Ultra-widefield fundus photograph.
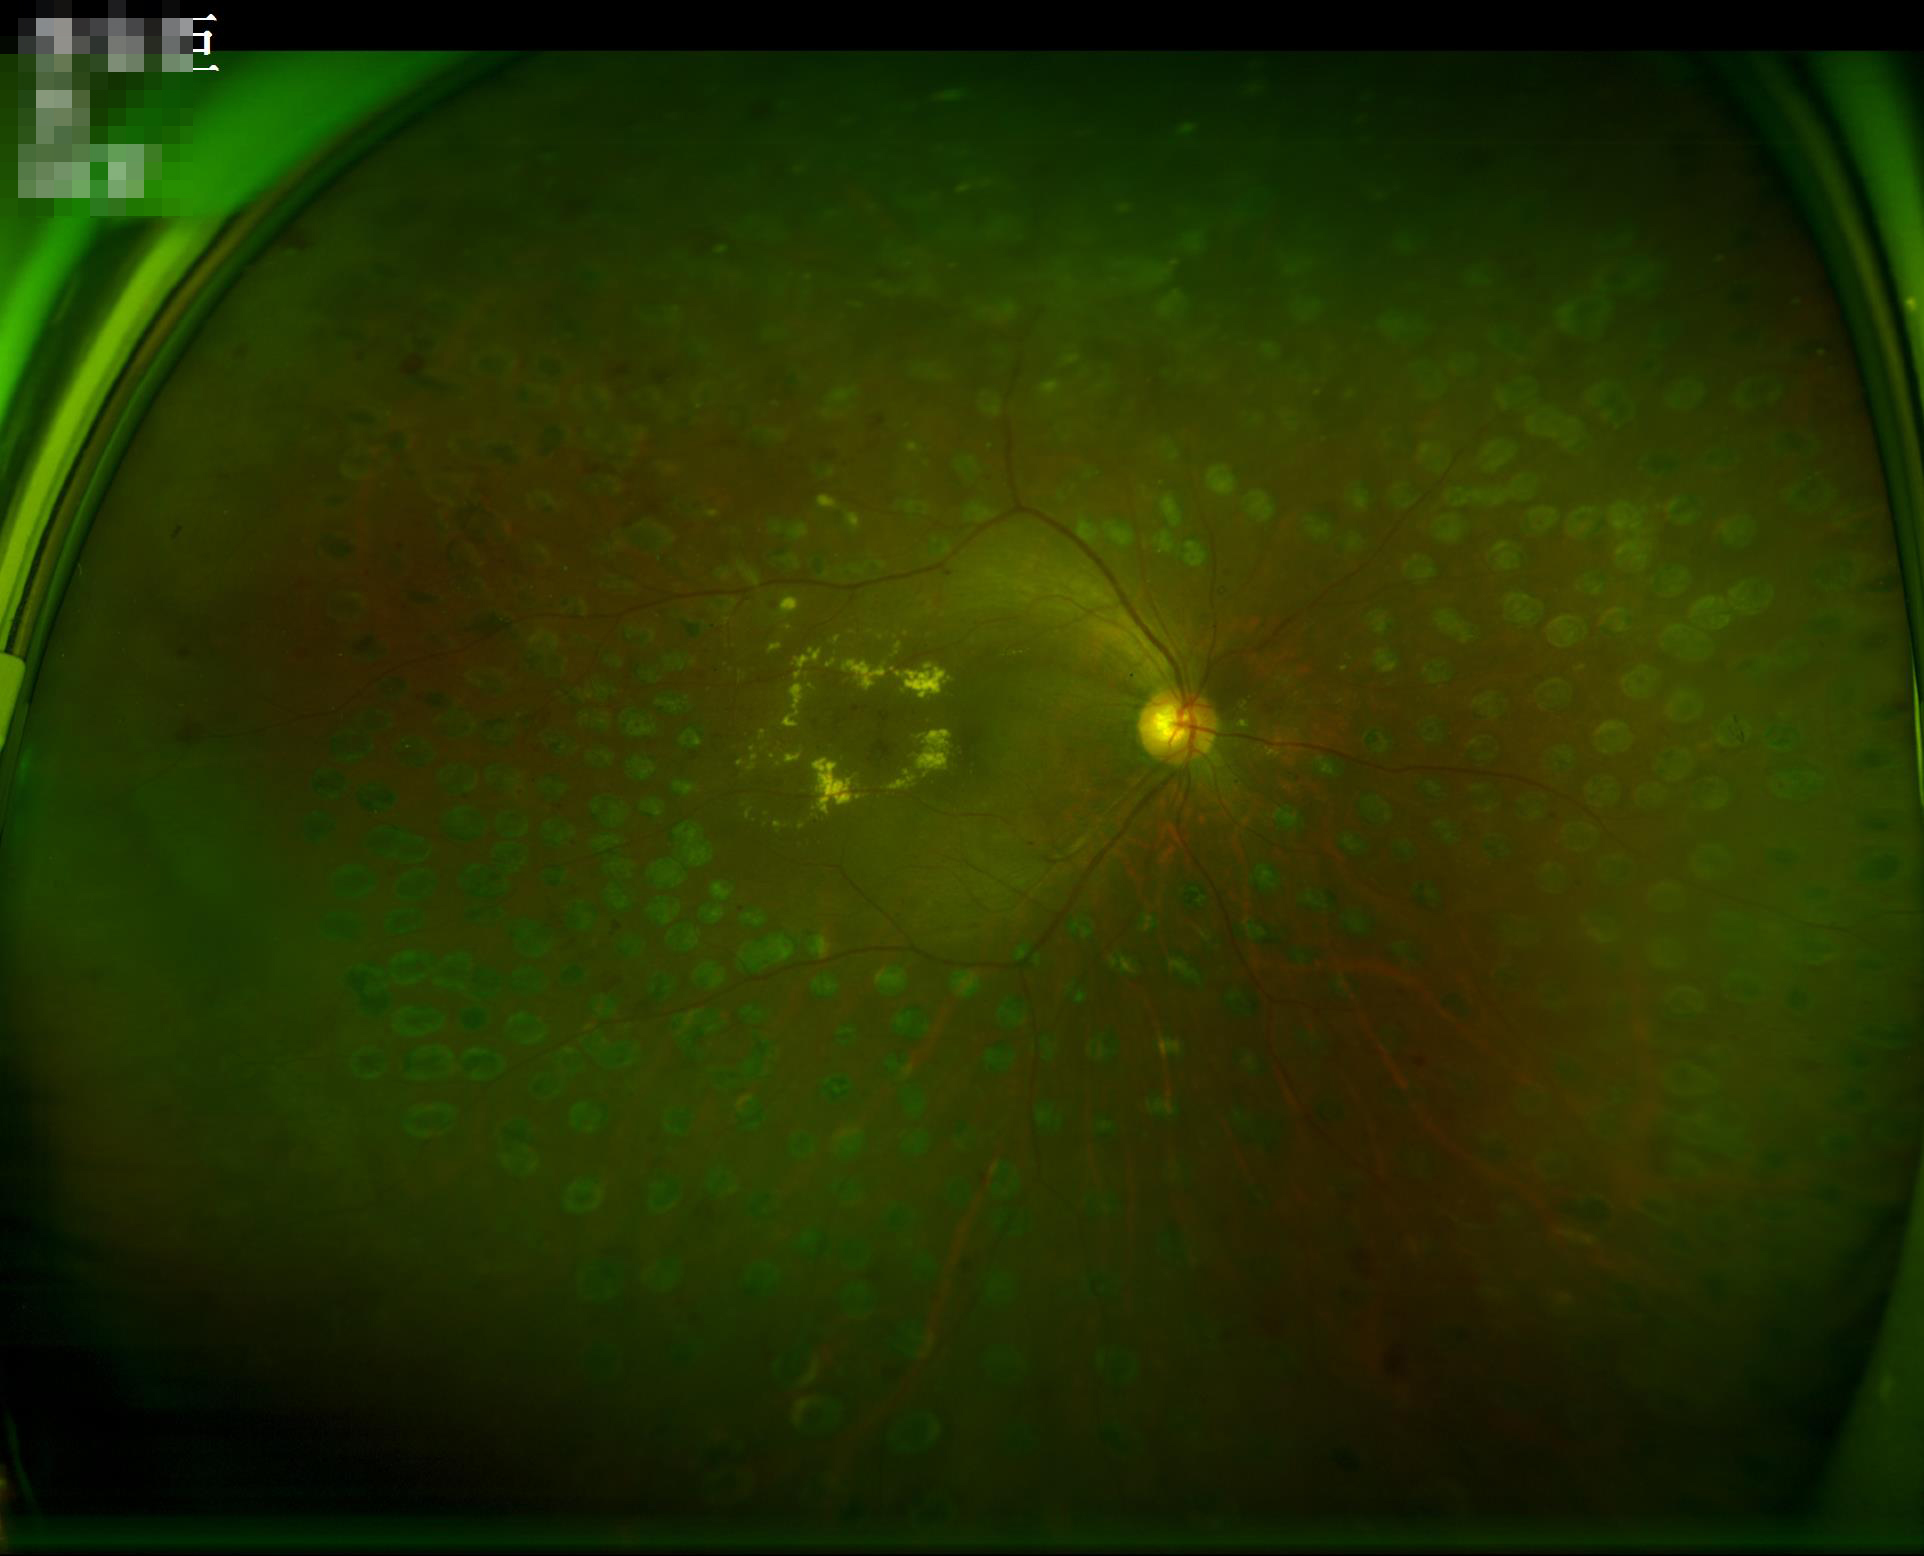 Overall = adequate for clinical interpretation
Clarity = sharp throughout the field
Contrast = low, vessels and details hard to distinguish